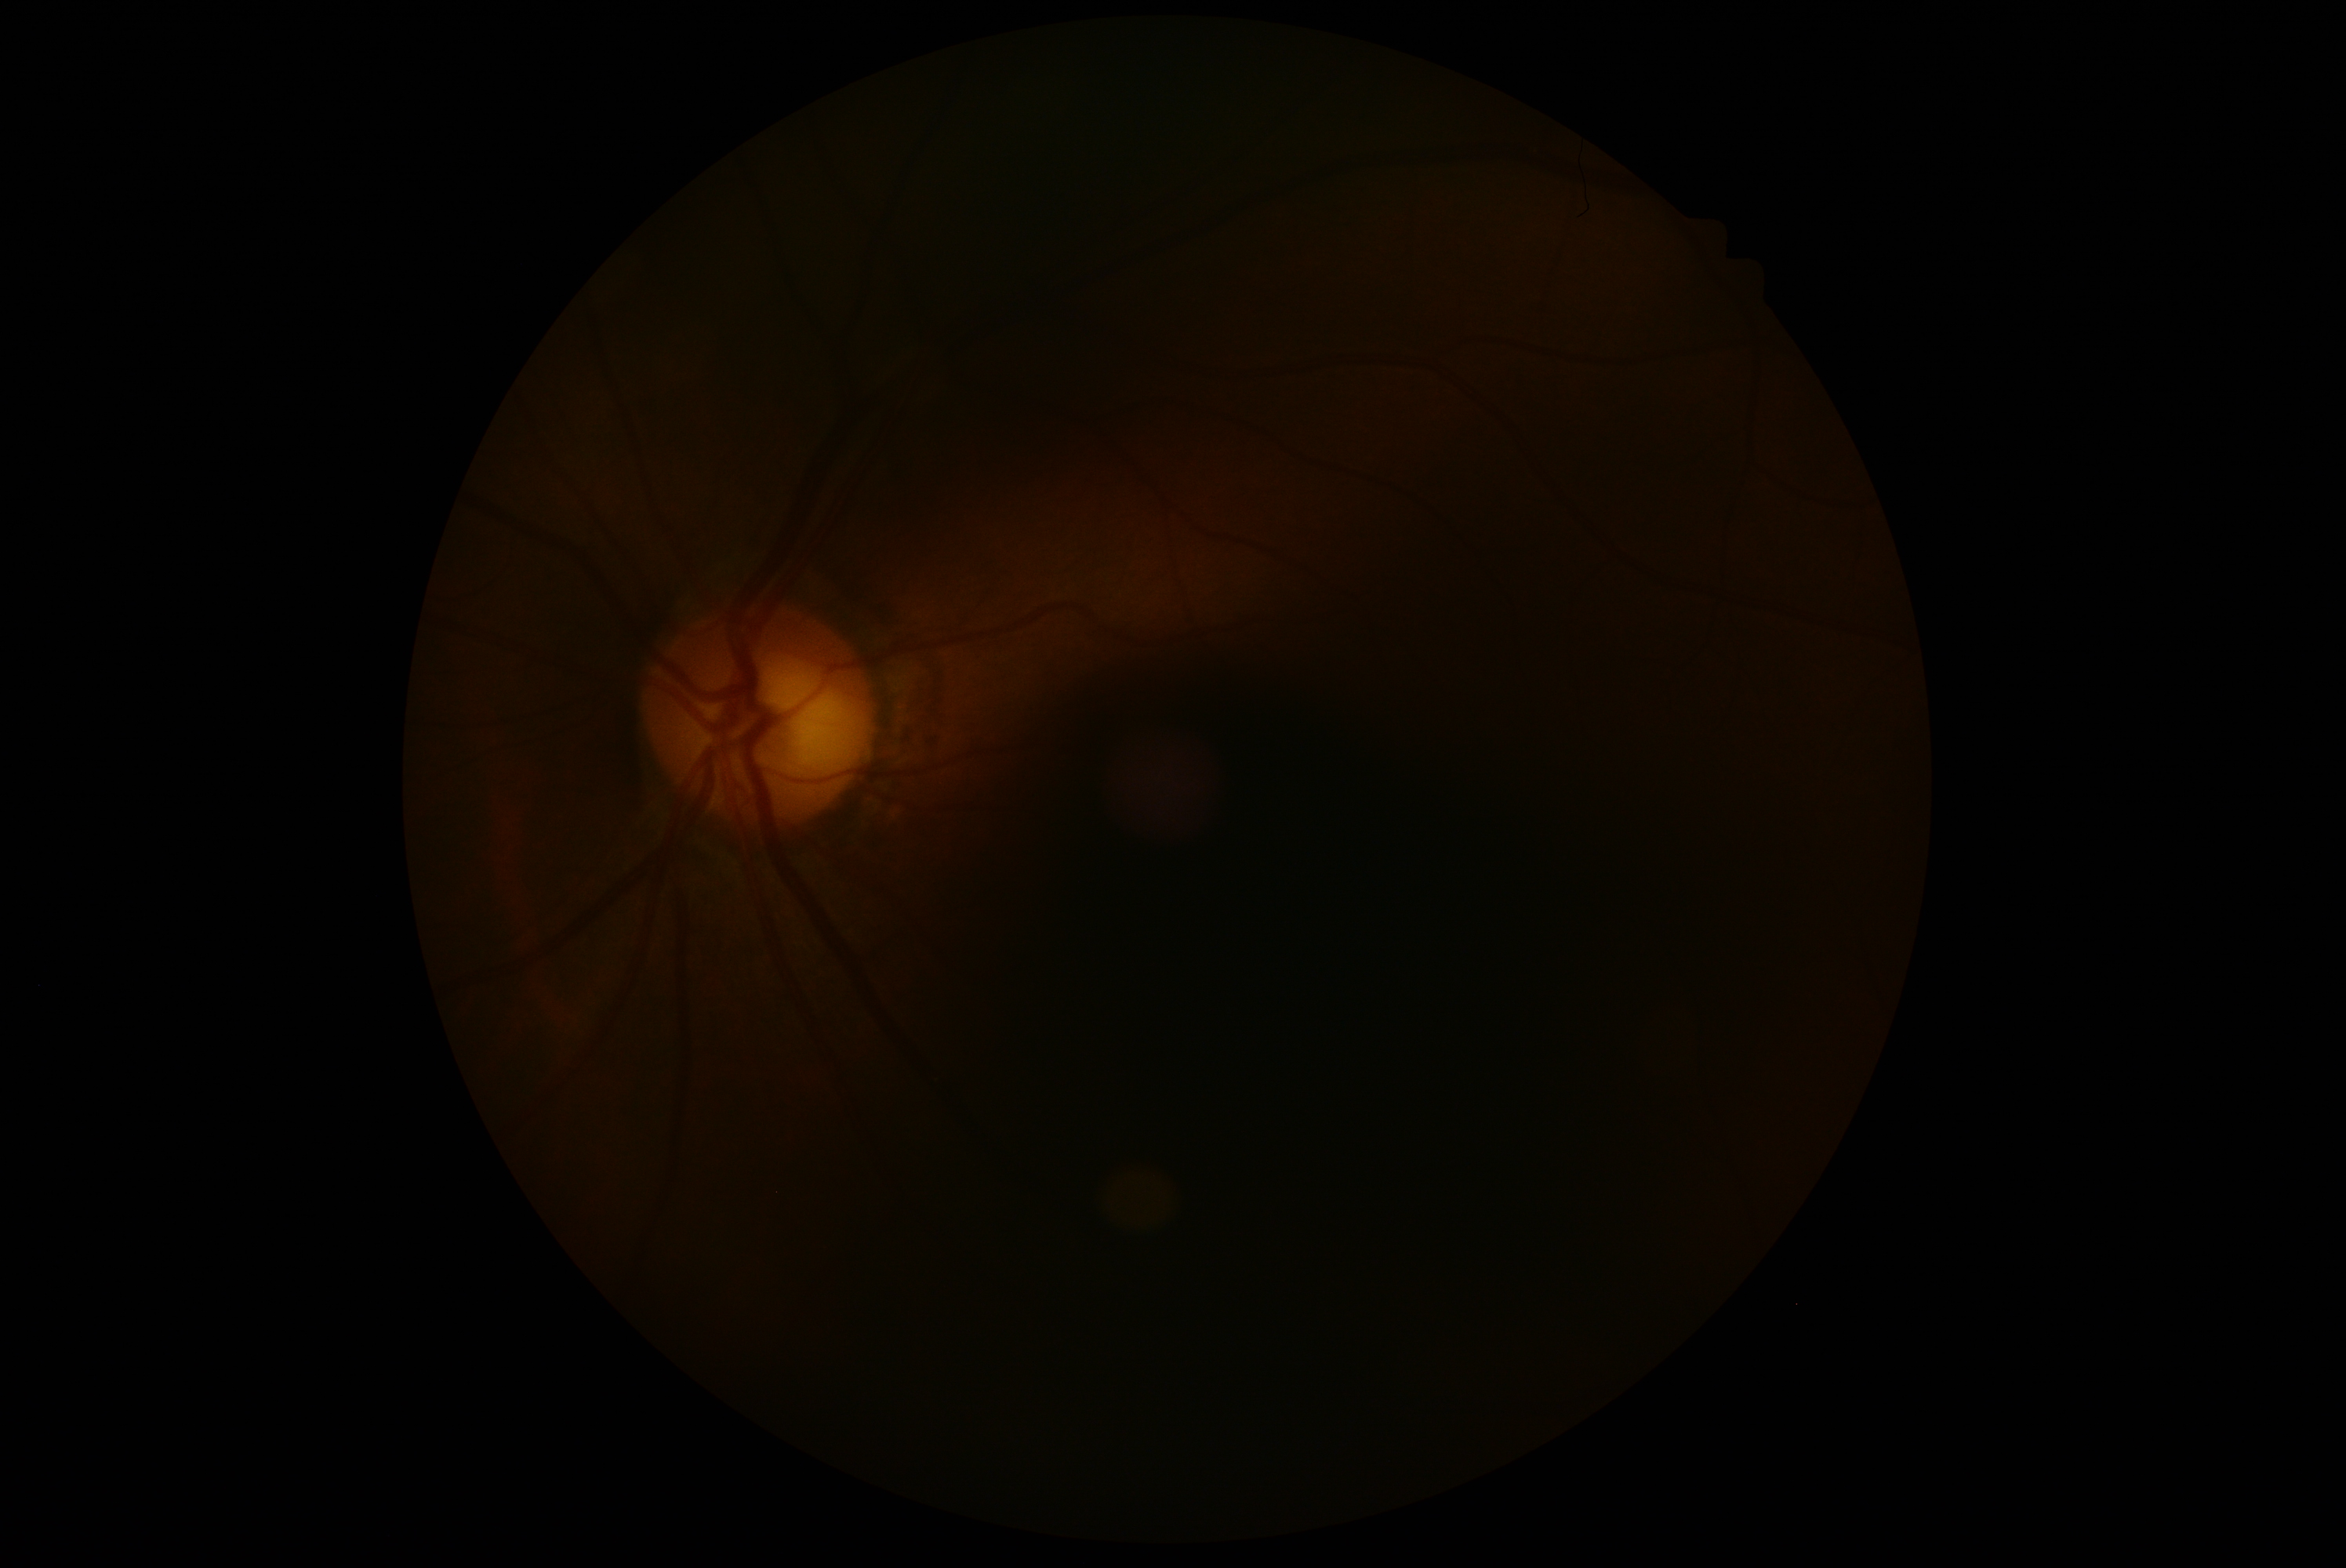
DR stage = ungradable due to poor image quality.